Image size 1932x1932 — 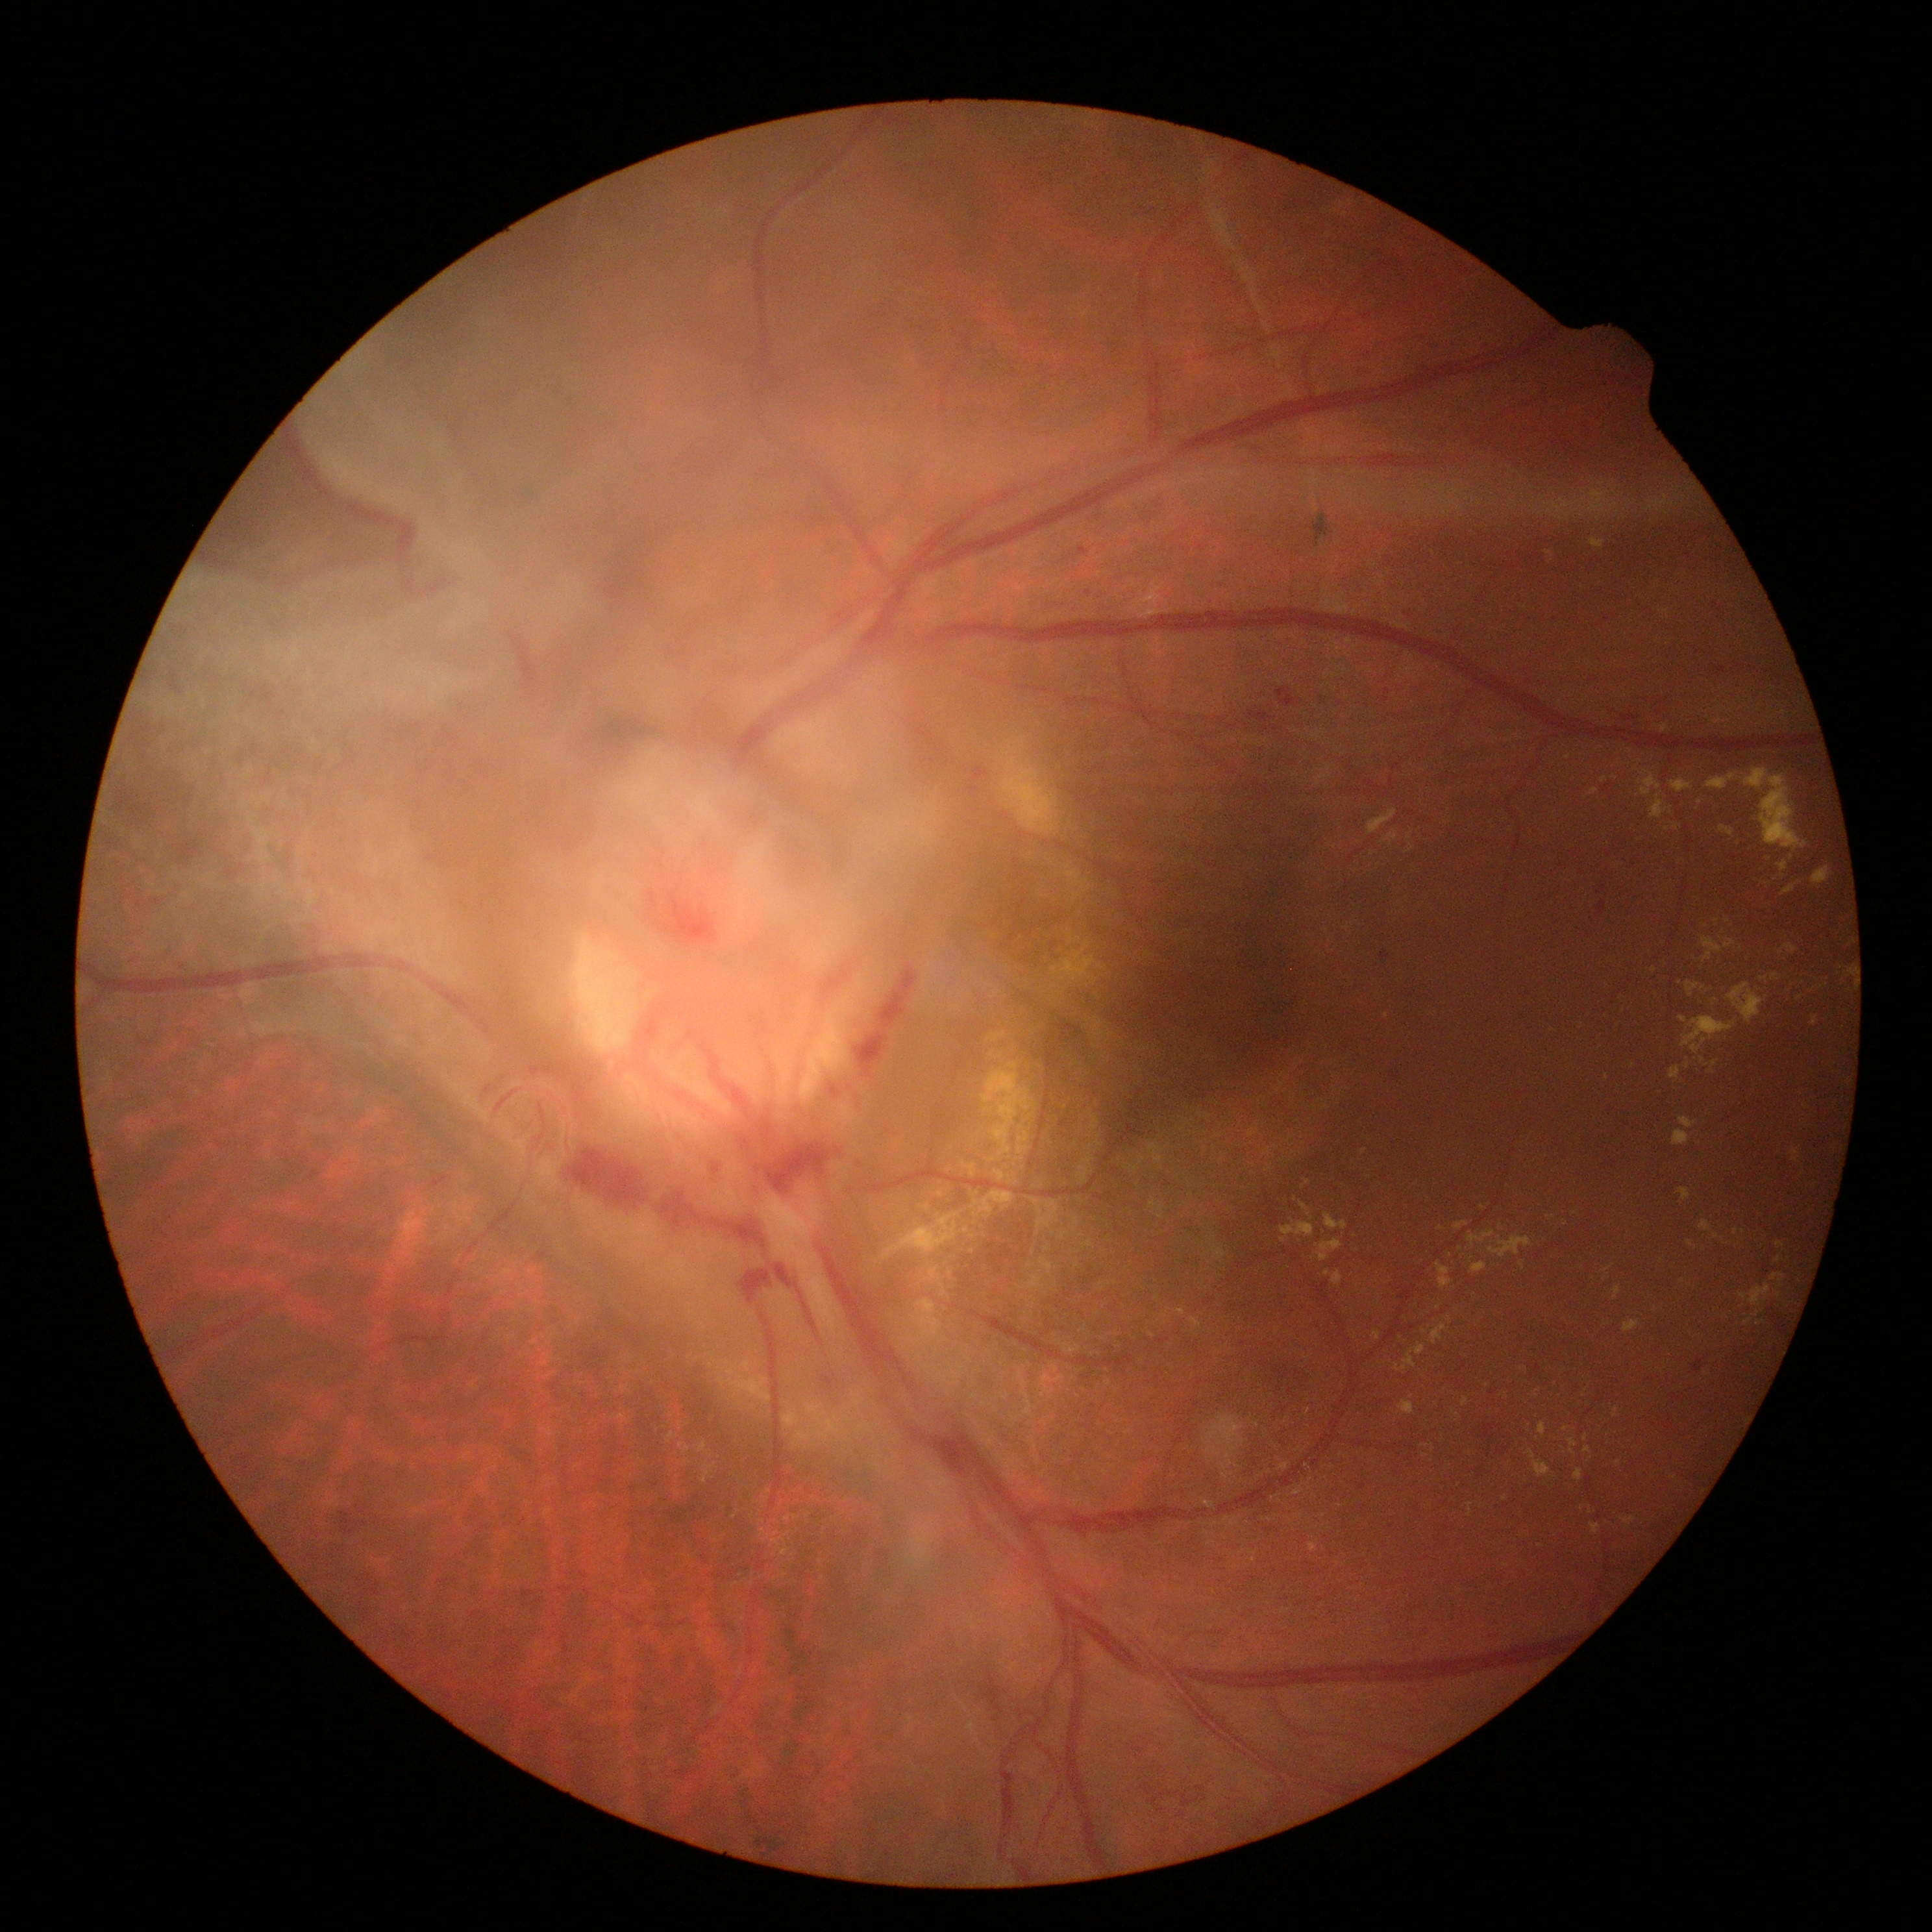 Diabetic retinopathy severity is grade 4 (PDR) — neovascularization and/or vitreous/pre-retinal hemorrhage.